Modified Davis grading: 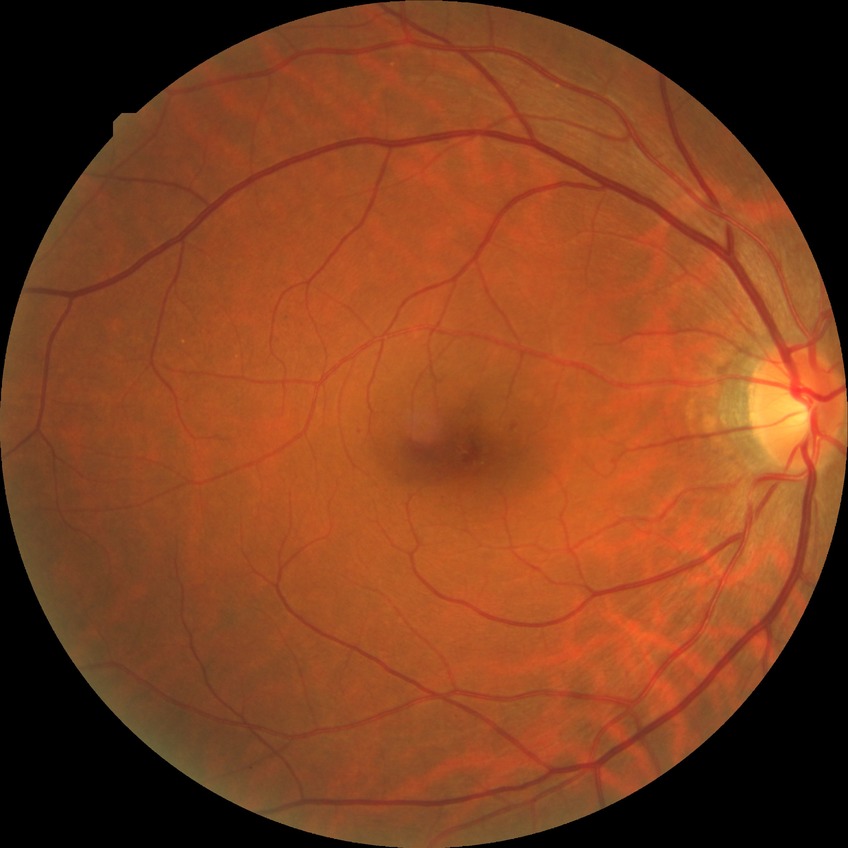
DR severity: SDR.